45° field of view:
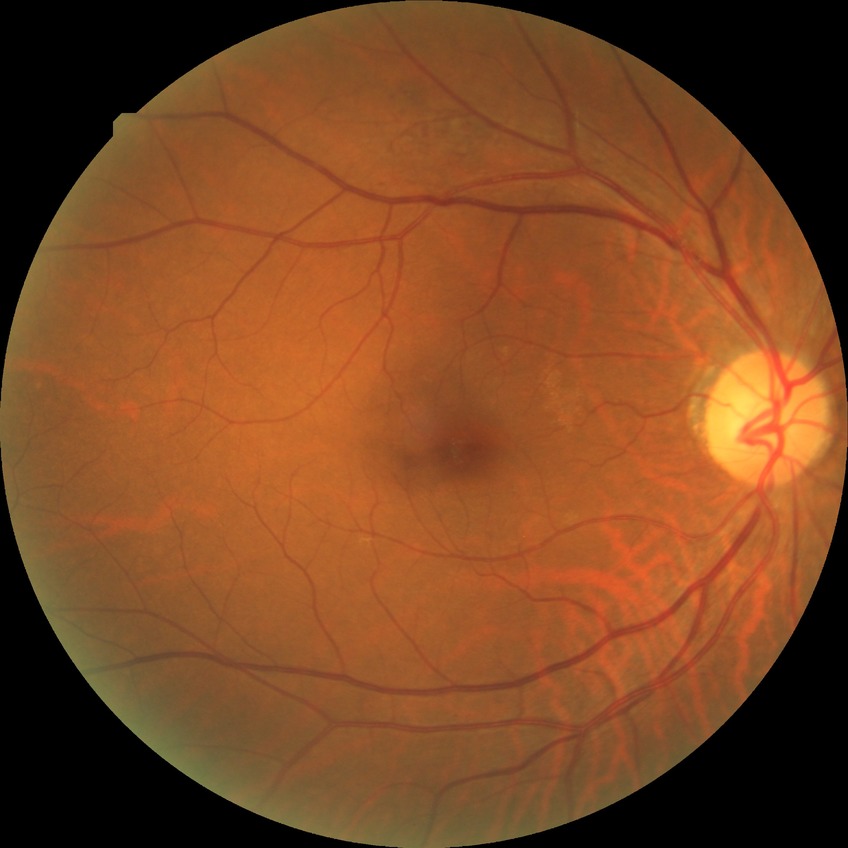

DR severity: NDR.
No apparent diabetic retinopathy.